Wide-field contact fundus photograph of an infant.
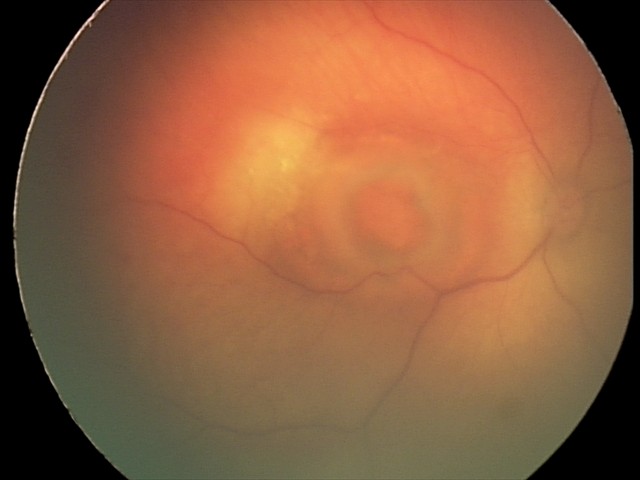 Q: What is the diagnosis from this examination?
A: toxoplasmosis chorioretinitis